Field includes the optic disc and macula · acquired with a Topcon TRC-50DX
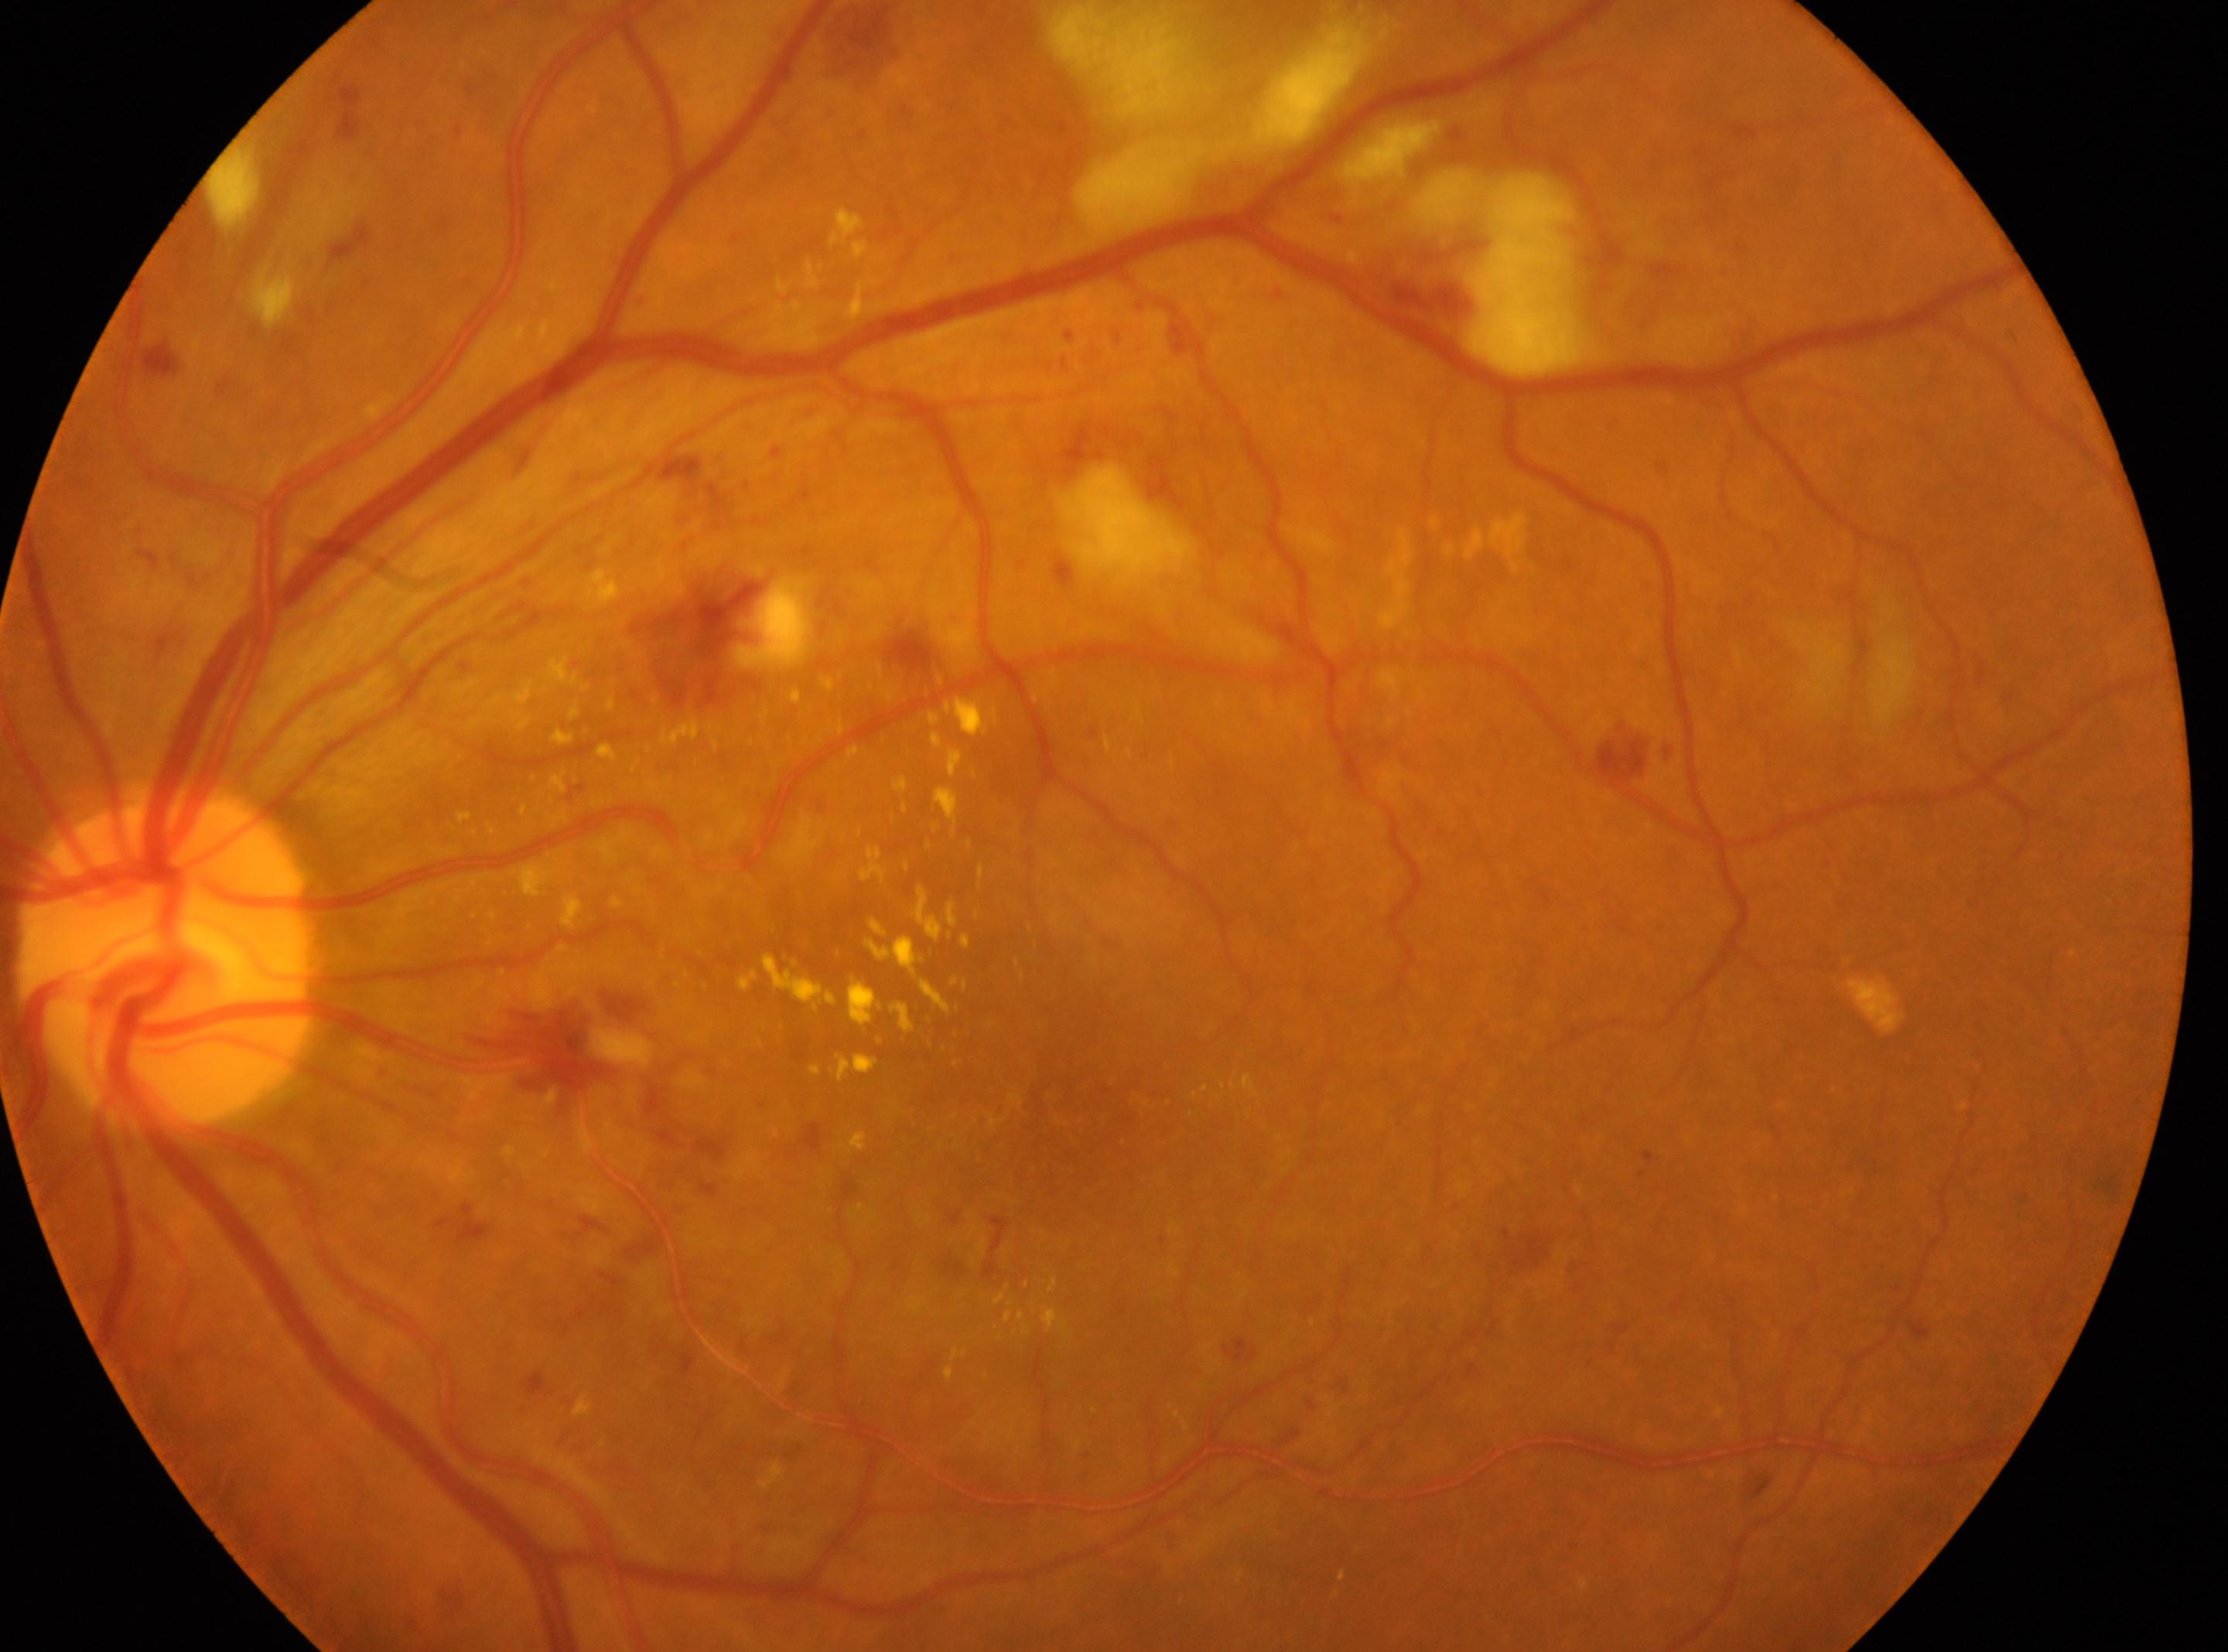 Annotations:
* macular center: (1040, 1112)
* laterality: the left eye
* retinopathy: grade 3 (severe NPDR)
* DR class: non-proliferative diabetic retinopathy
* disc center: (166, 961)